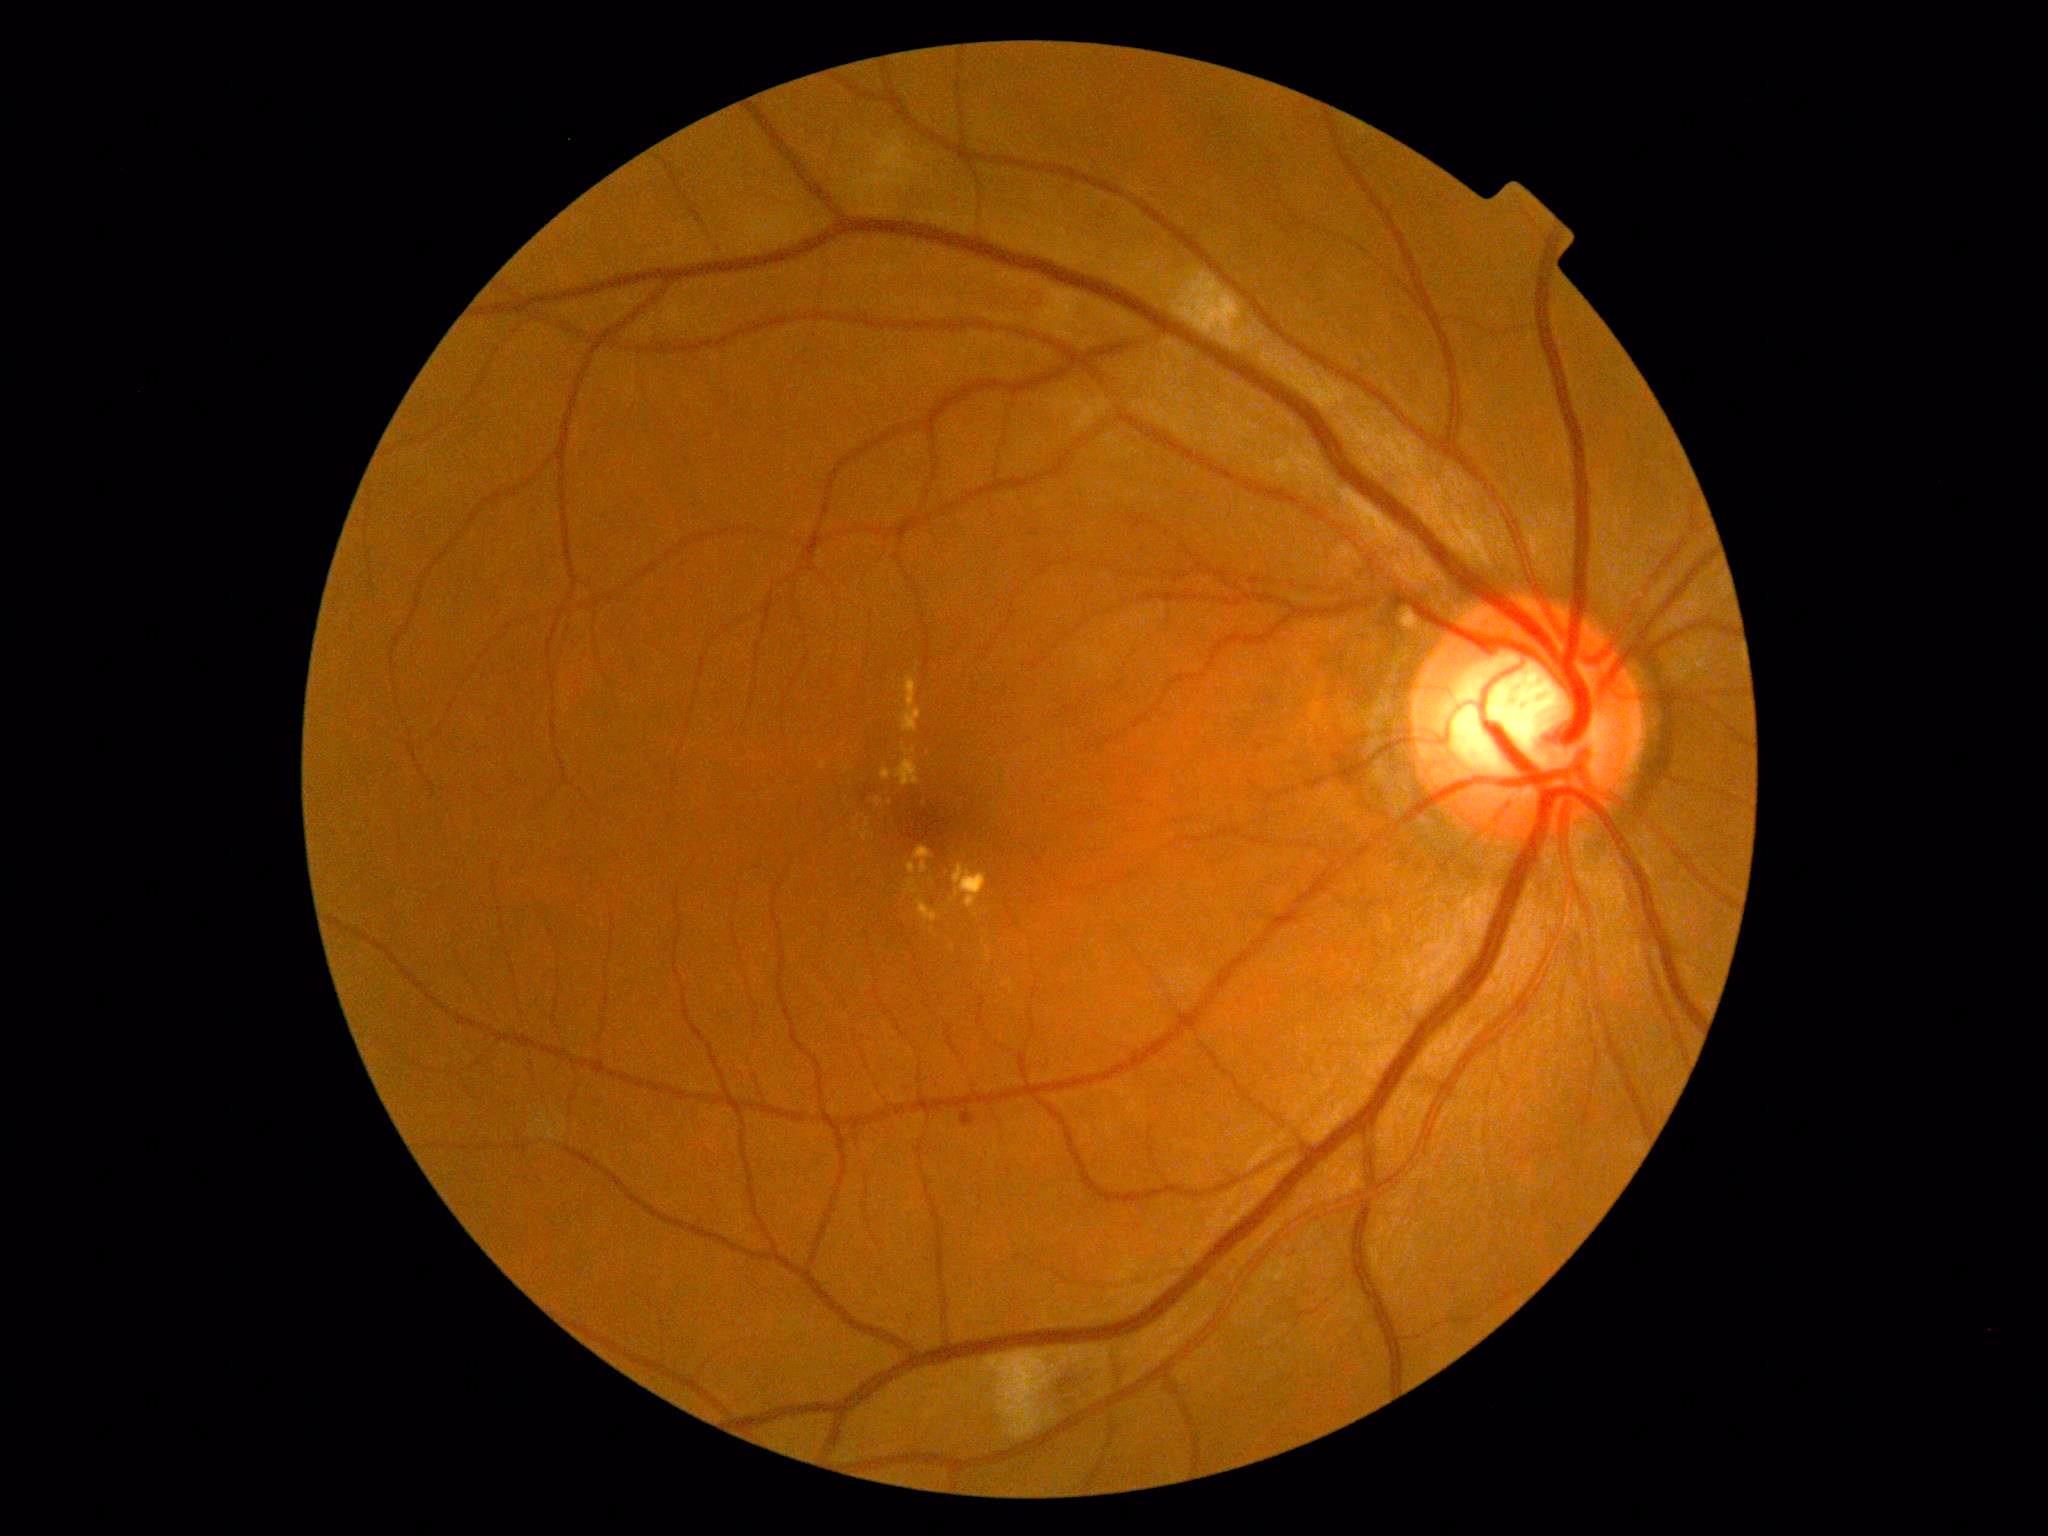 {"partial": true, "dr_grade": 2, "lesions": {"se": [[985, 1351, 1059, 1439], [1187, 284, 1219, 324]], "he": [[1060, 1374, 1084, 1407], [1017, 288, 1041, 306]], "ex": [[908, 863, 916, 875], [881, 744, 921, 786], [865, 819, 871, 828], [950, 865, 987, 909], [861, 831, 874, 841], [913, 846, 933, 875], [905, 879, 919, 895], [902, 677, 922, 732], [875, 798, 882, 806], [918, 899, 938, 923]], "ex_small": [[984, 941], [858, 830], [890, 803], [931, 931], [977, 916], [952, 948]], "ma": [[962, 1112, 976, 1126]]}}